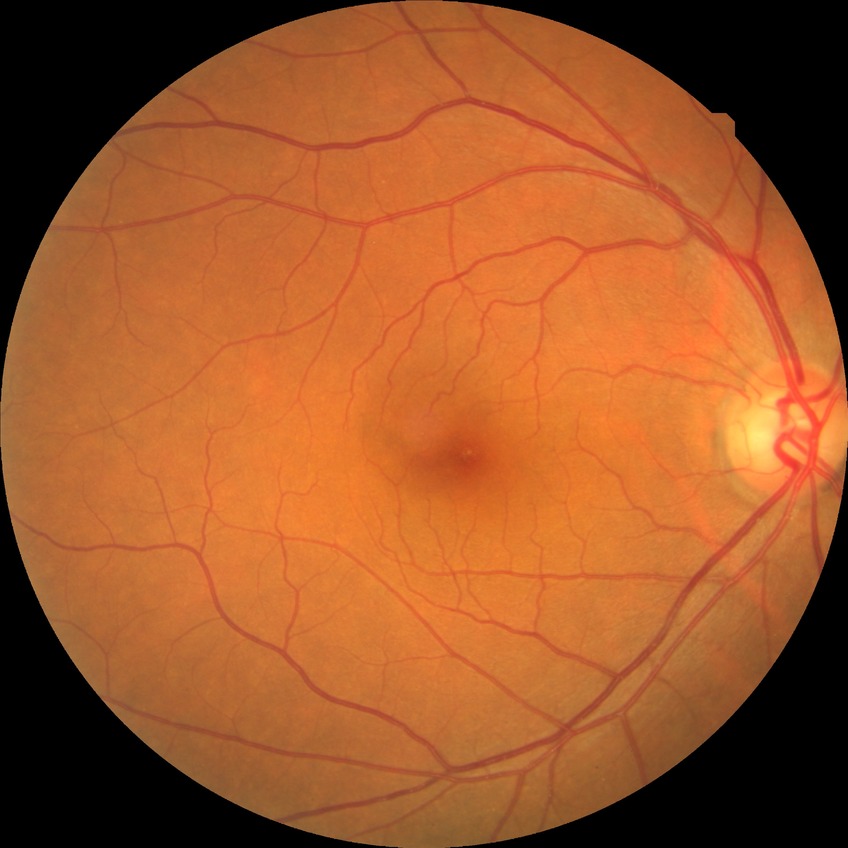
diabetic retinopathy (DR) = no diabetic retinopathy (NDR)